Color fundus photograph: 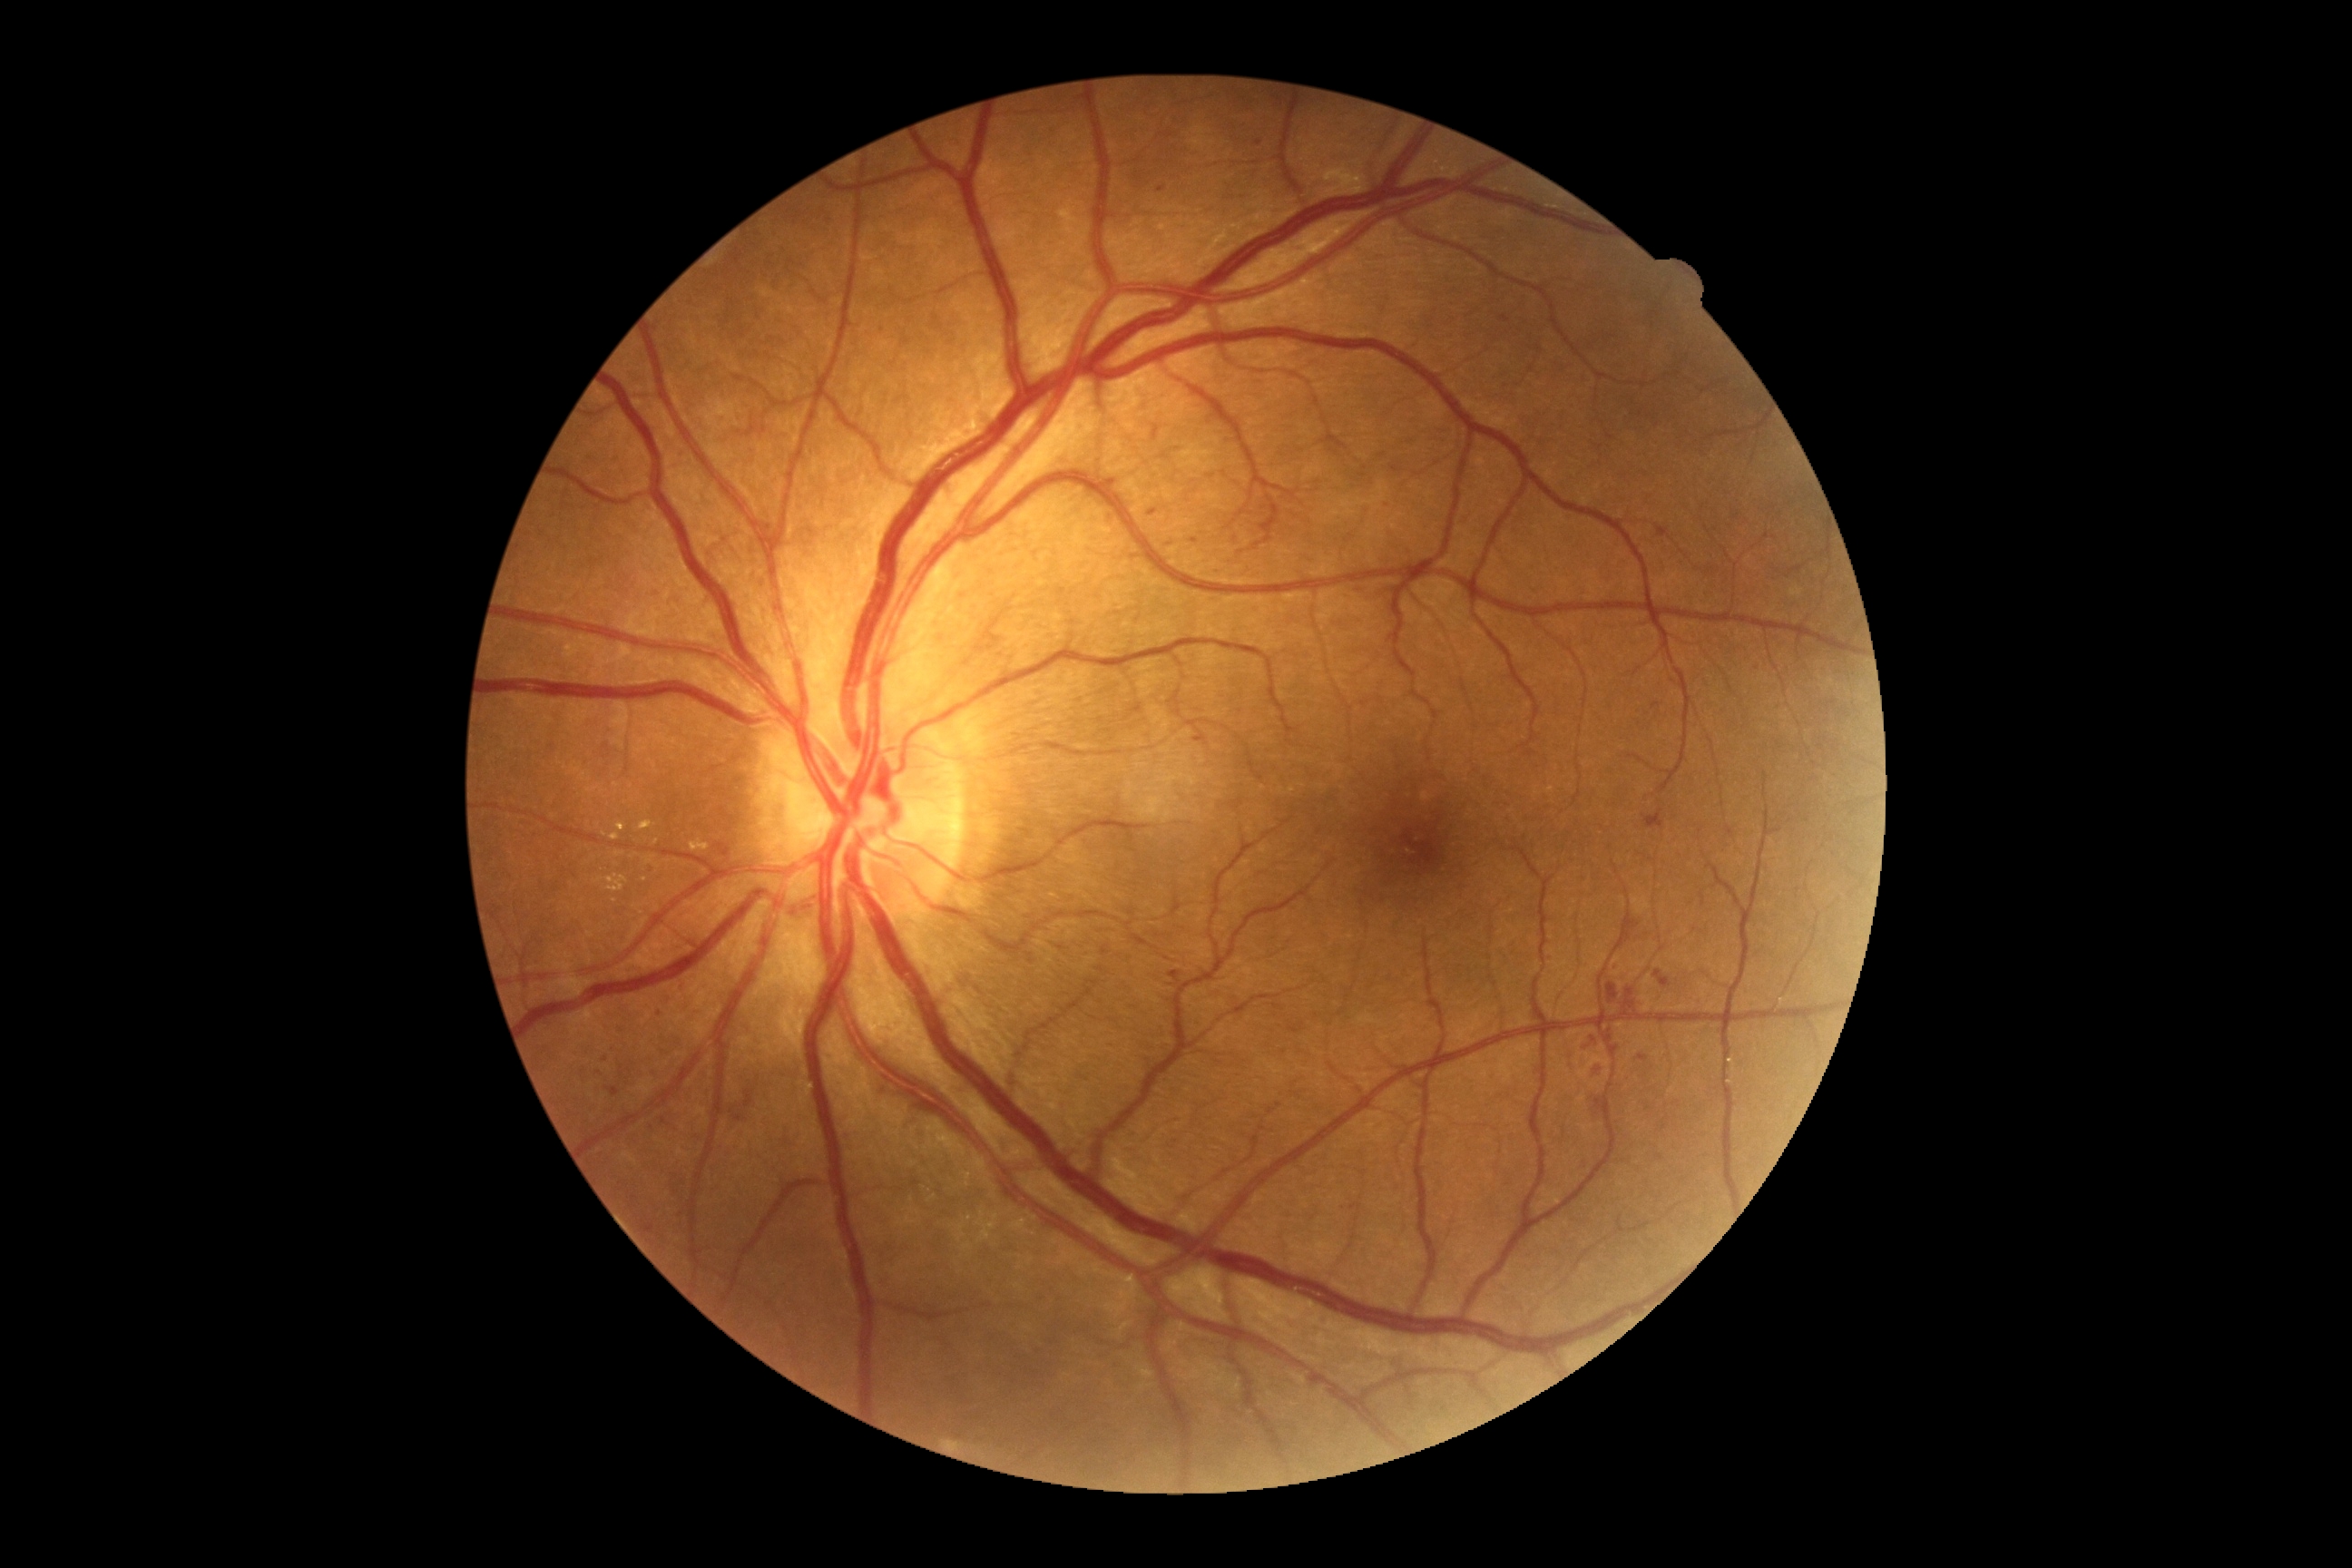
{"dr_category": "non-proliferative diabetic retinopathy", "dr_grade": "grade 2"}